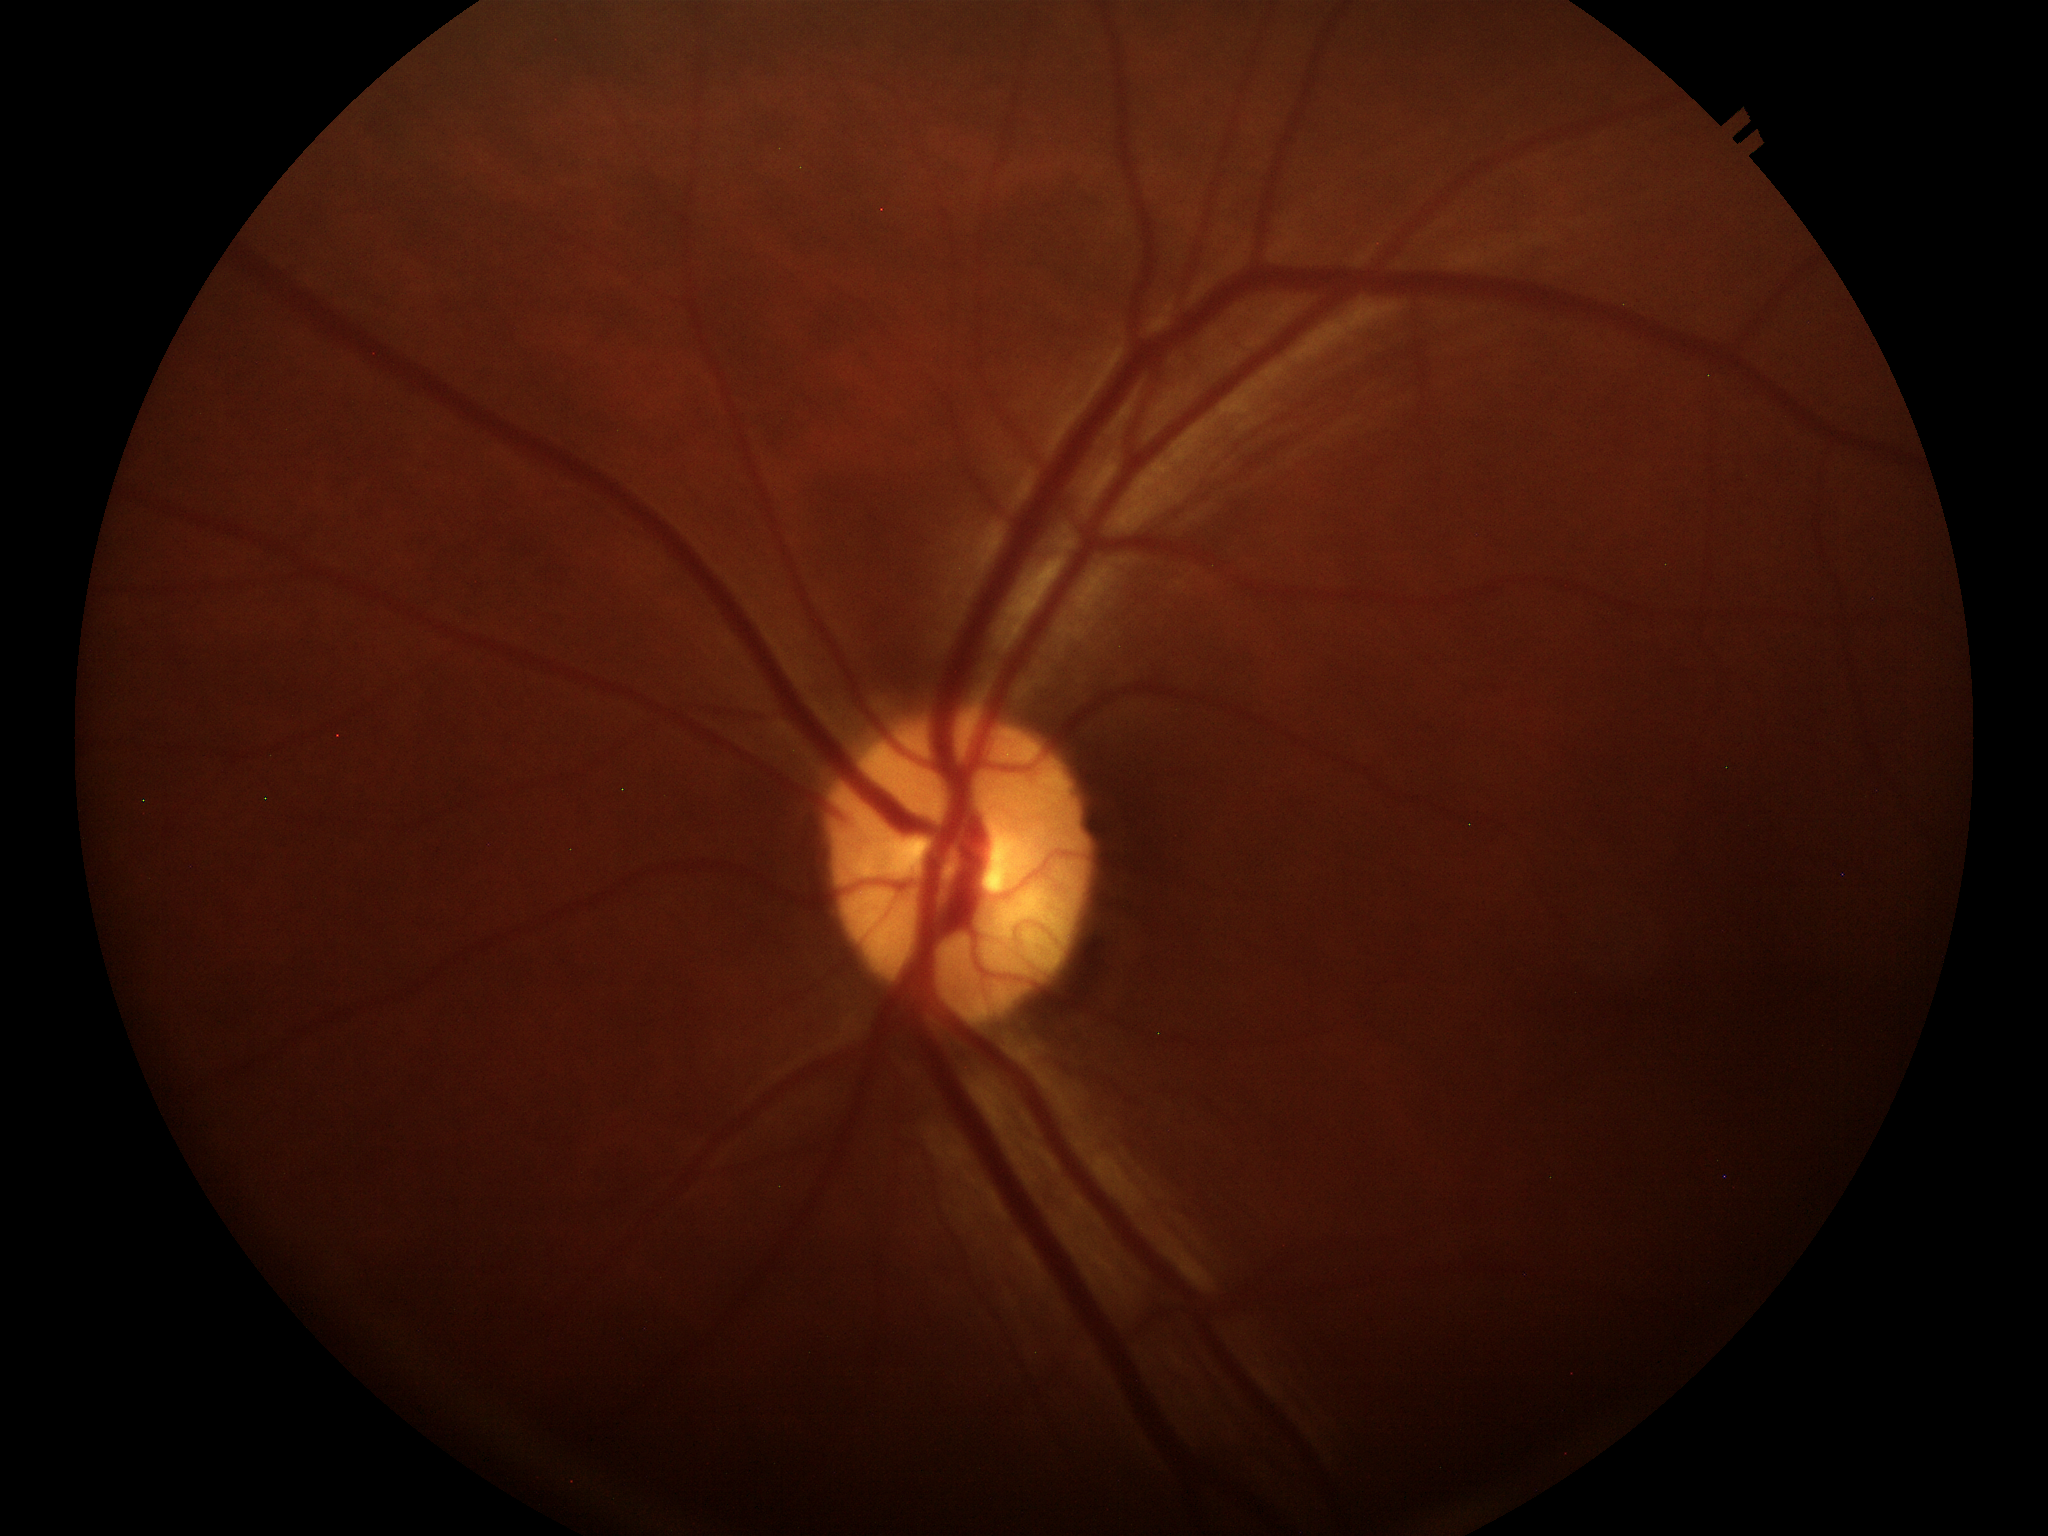 Glaucoma impression: not suspect
horizontal CDR: 0.48
vertical C/D ratio: 0.44